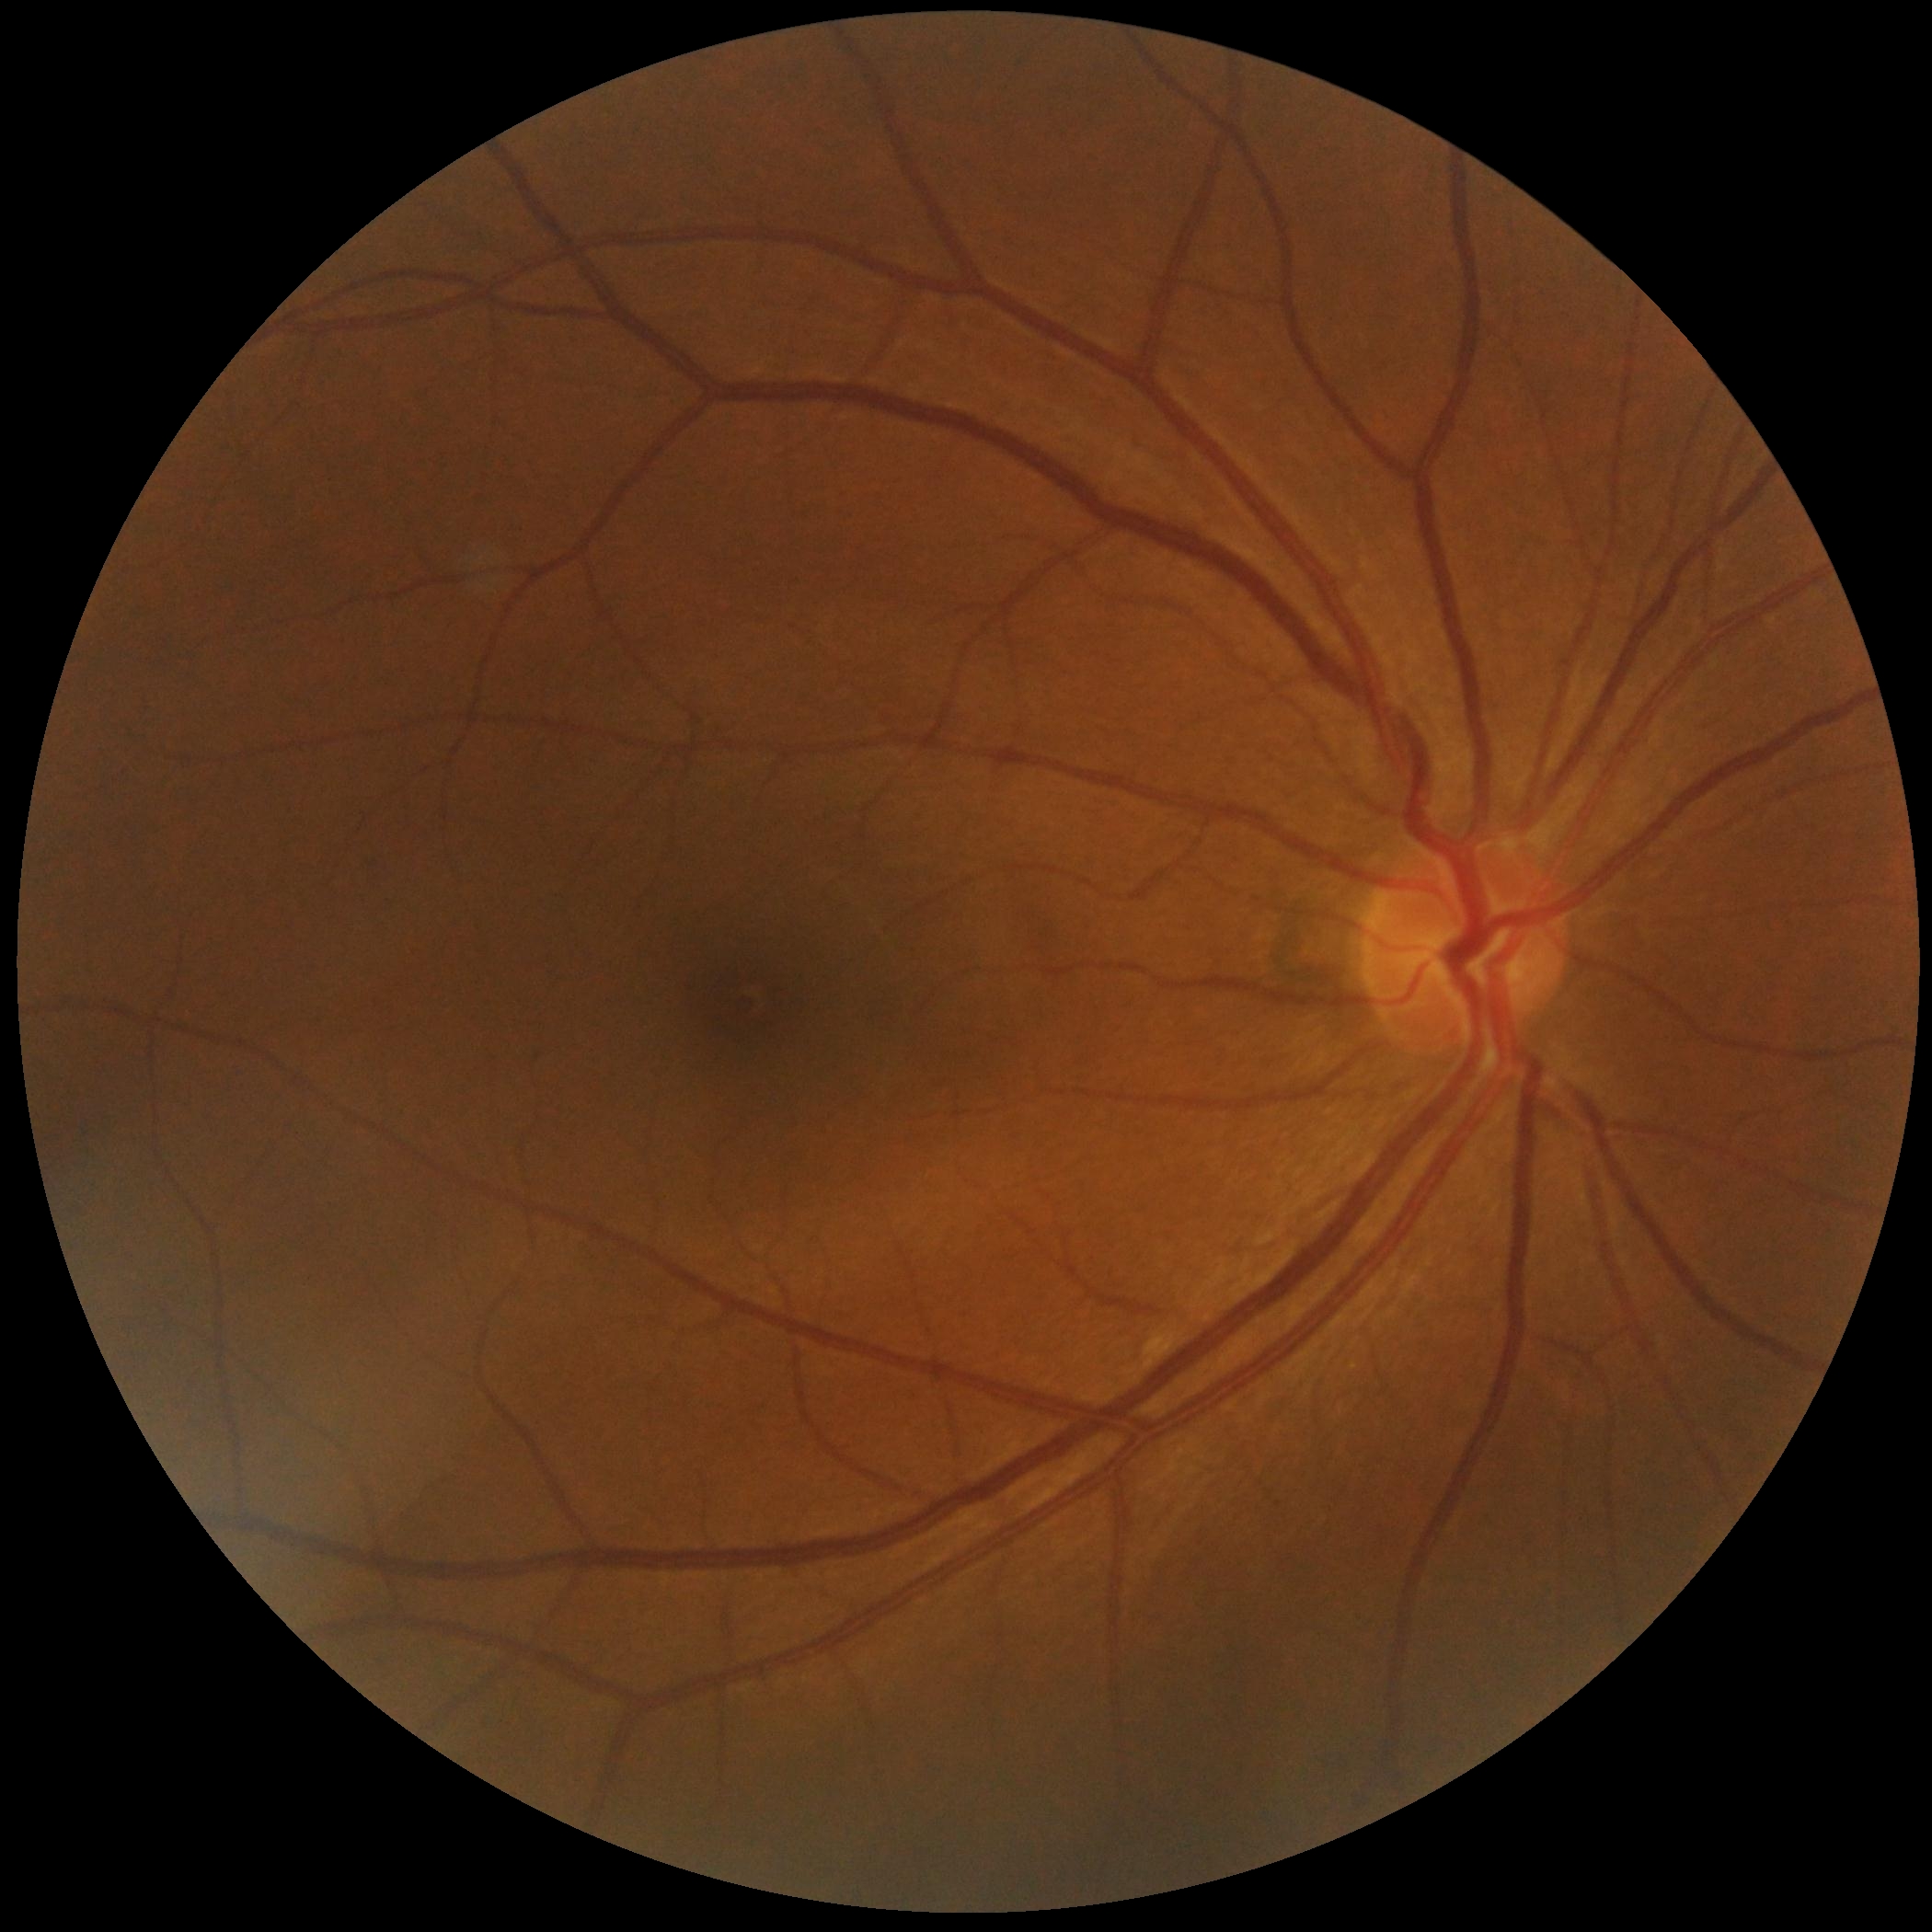

diabetic retinopathy (DR) = no apparent retinopathy (grade 0).